Wide-field retinal mosaic image — 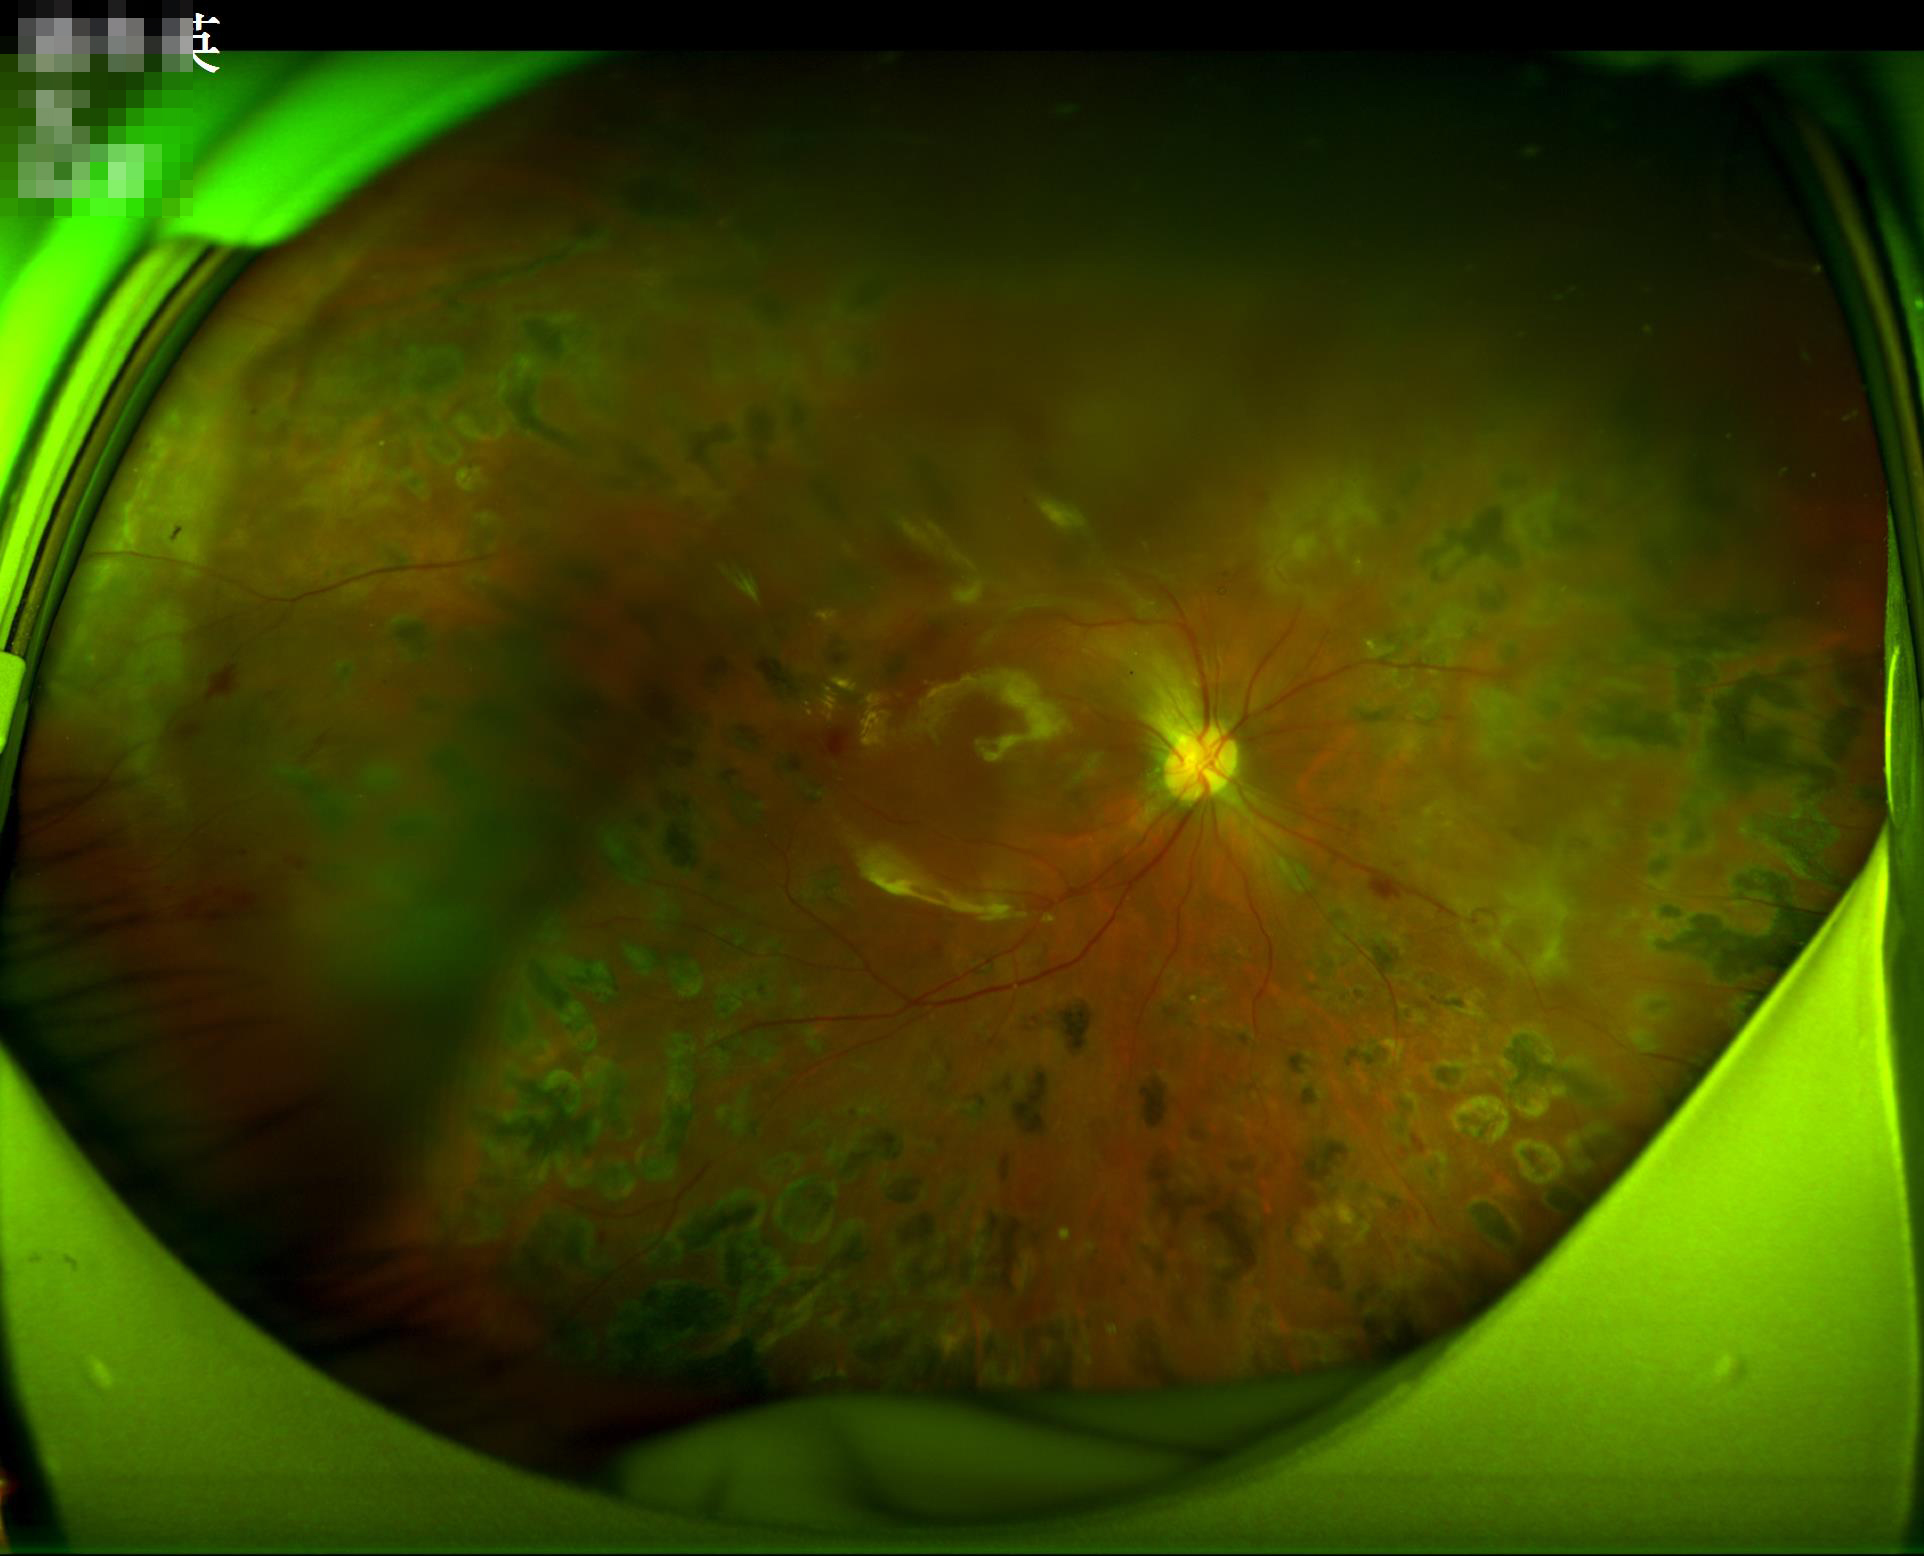 Image quality is suboptimal.
Illumination and color are suboptimal.
Out of focus; structures are indistinct.
Vessels and details are readily distinguishable.